2352 by 1568 pixels
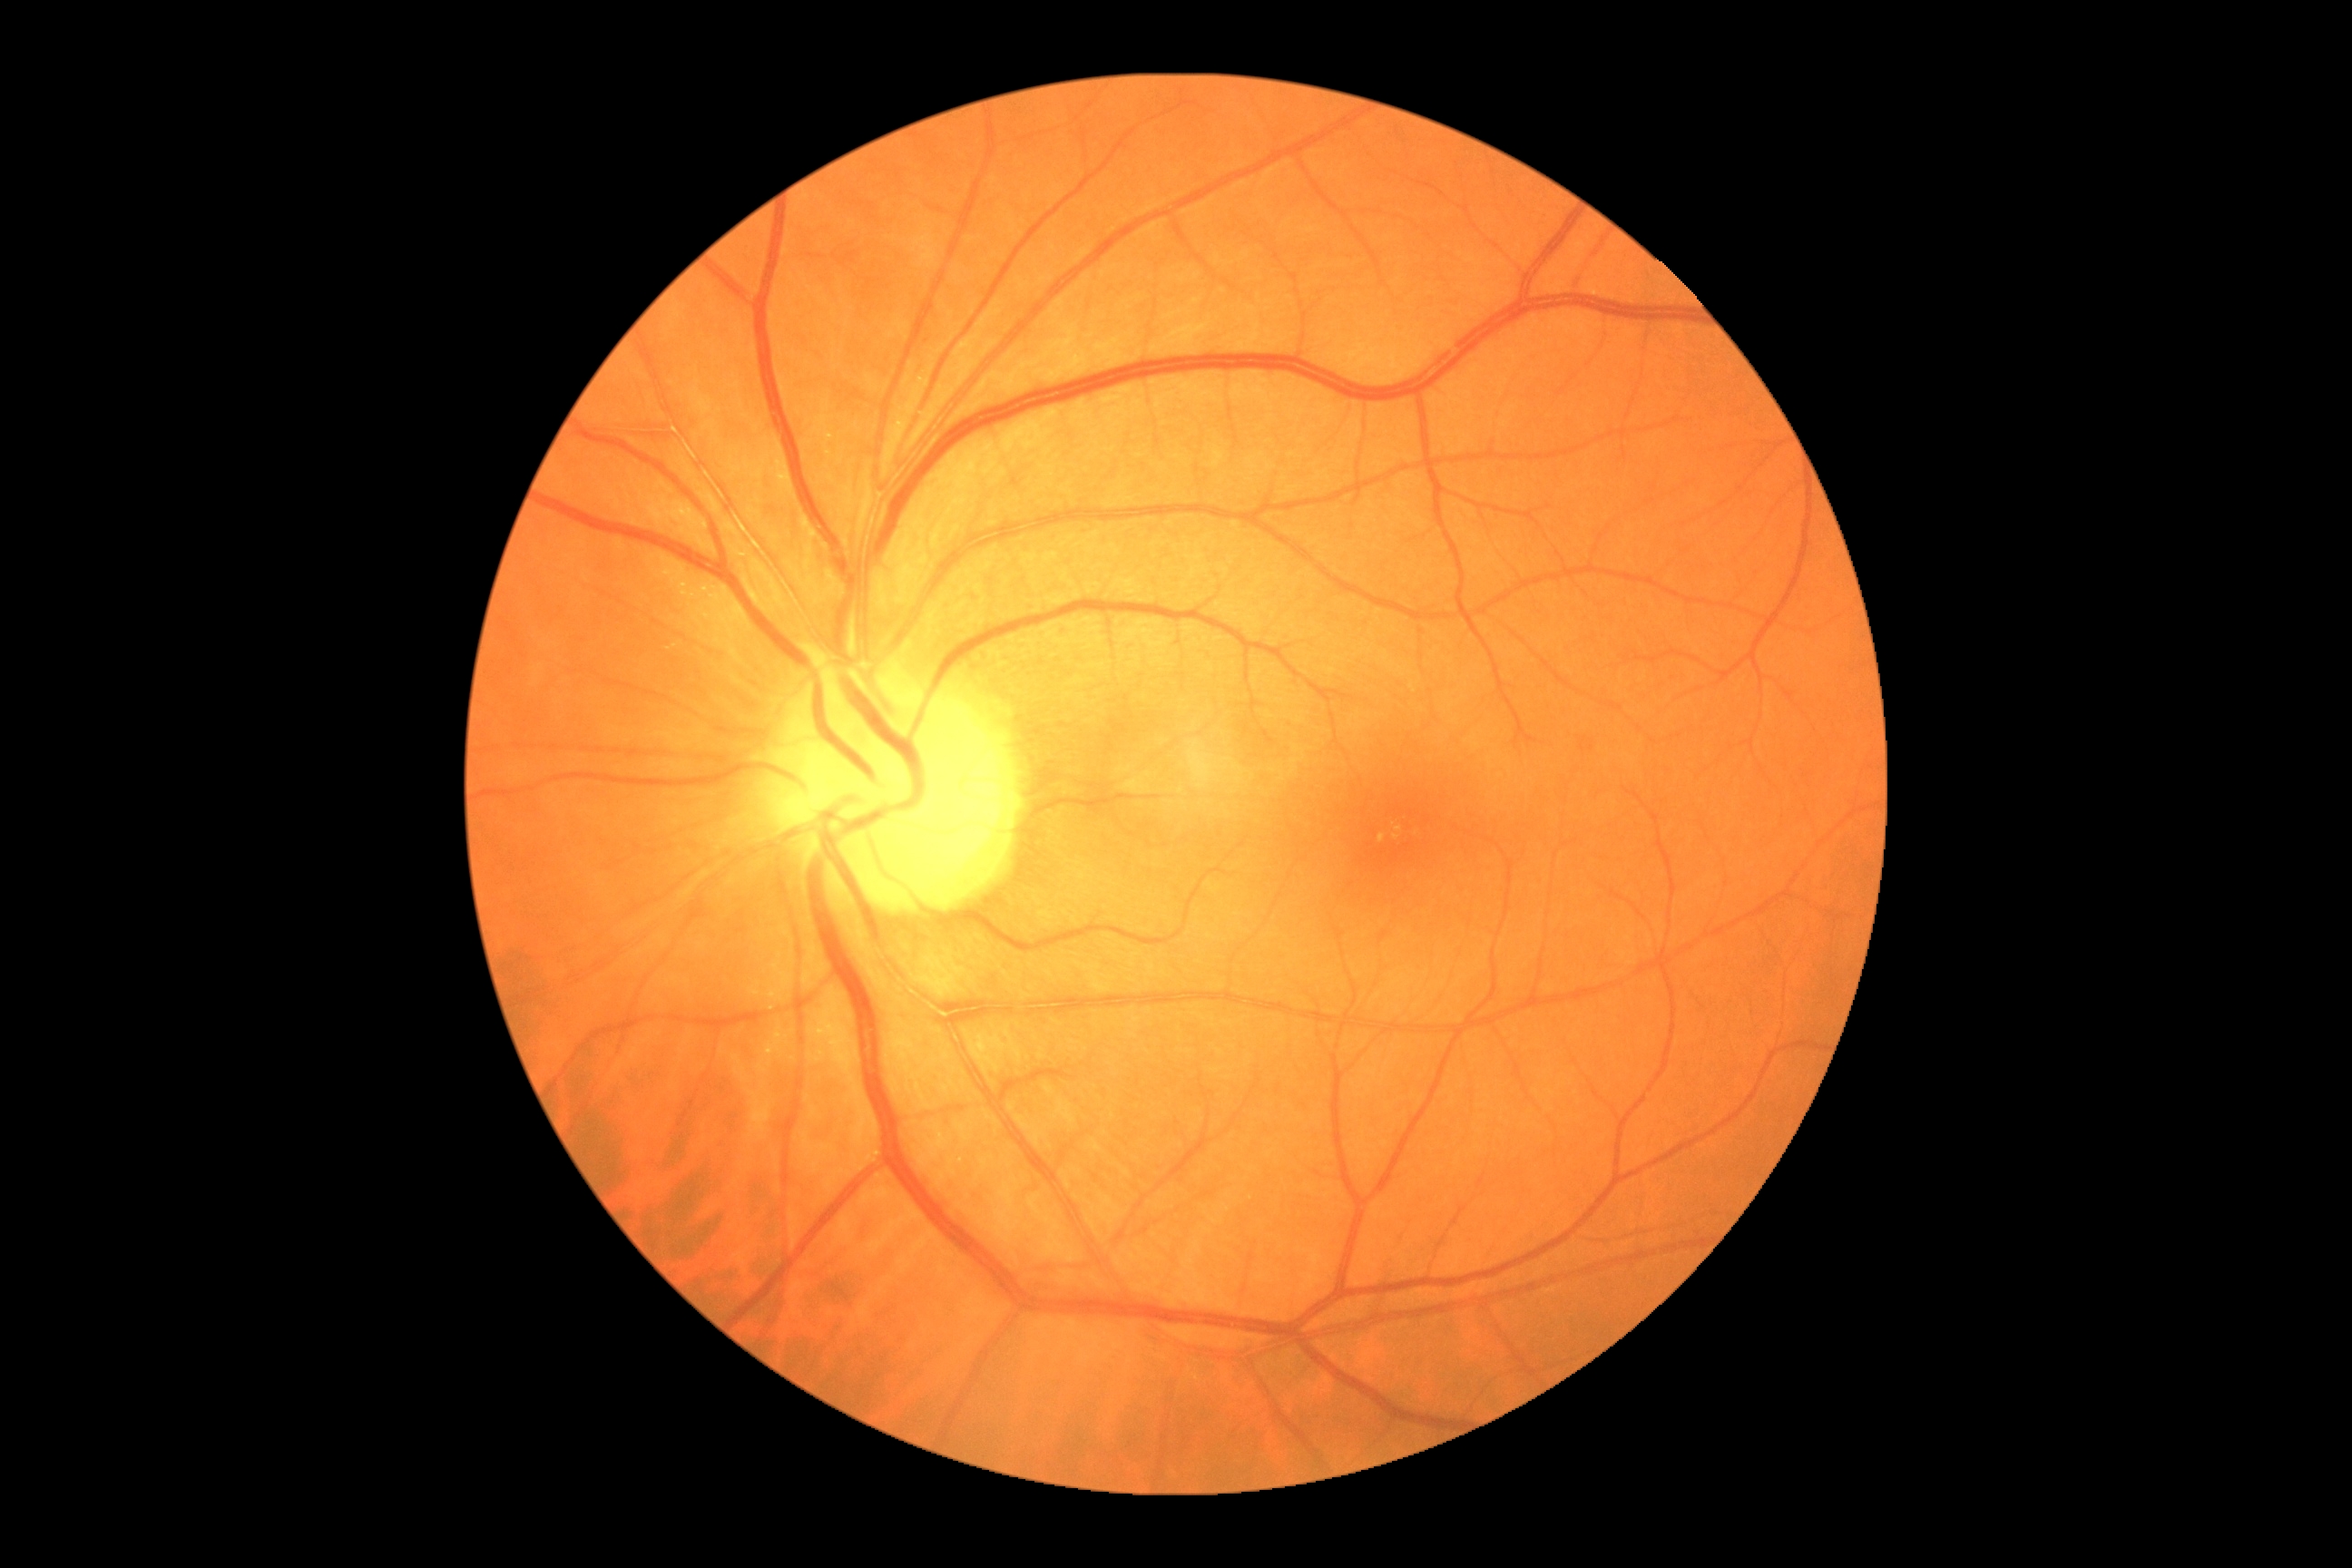   dr_grade: grade 0